Without pupil dilation:
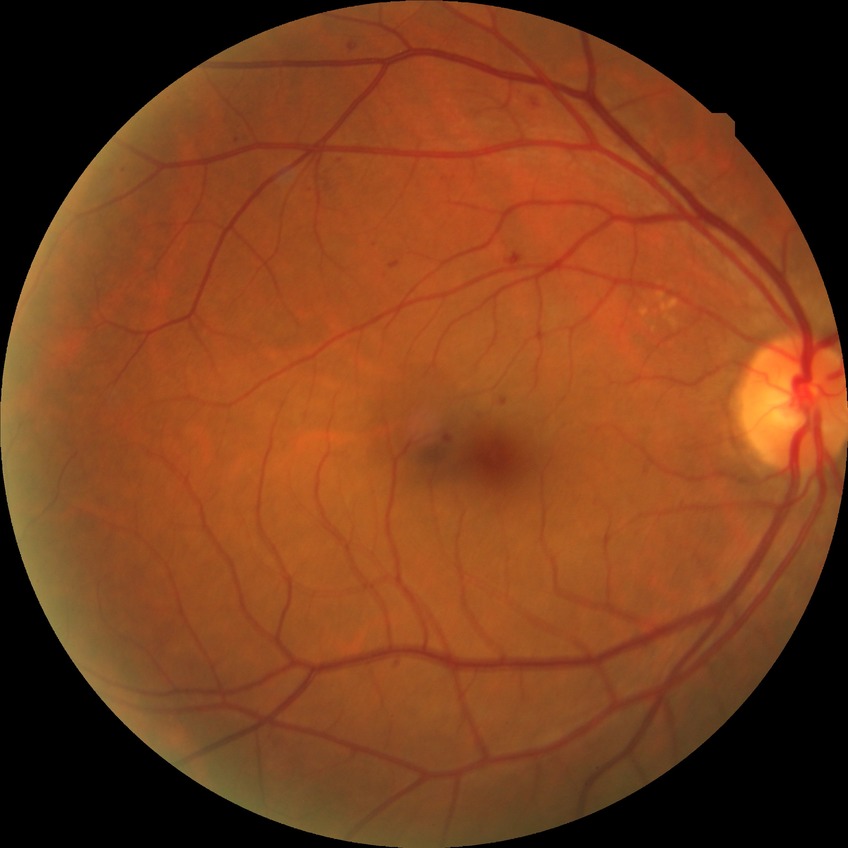
Diabetic retinopathy (DR) is SDR (simple diabetic retinopathy).
Disease class: non-proliferative diabetic retinopathy.